45° field of view:
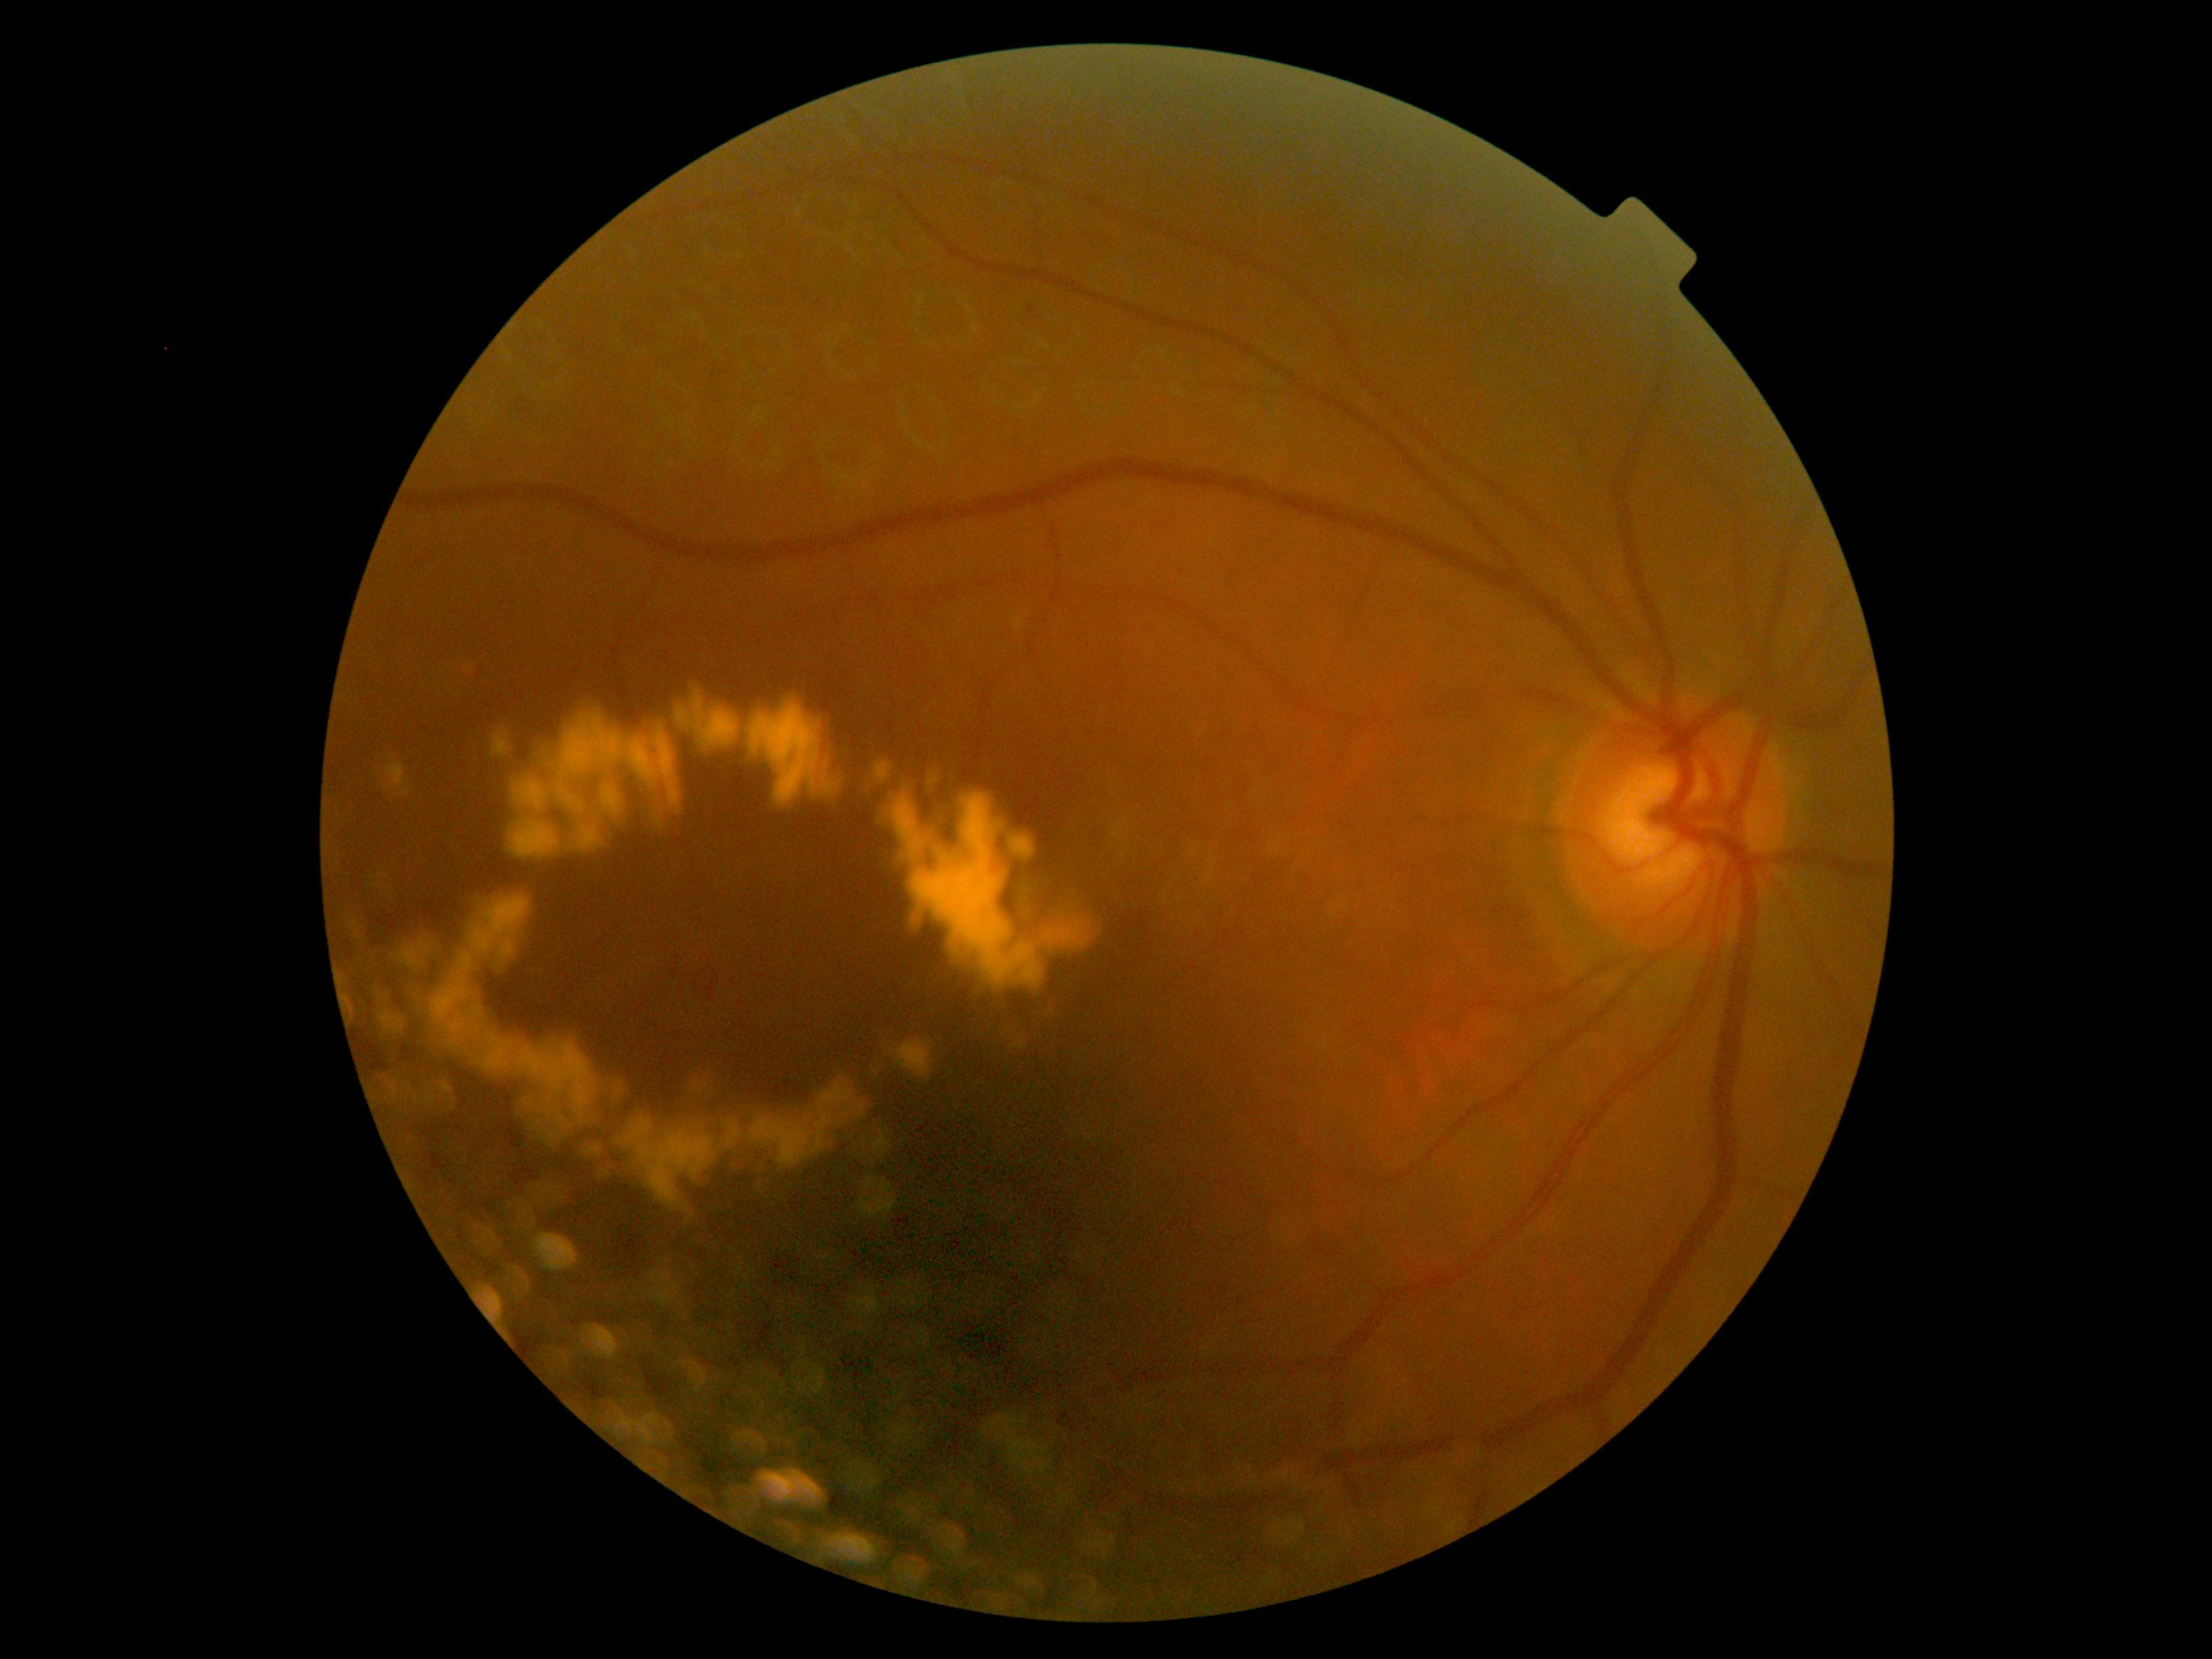

DR severity is moderate non-proliferative diabetic retinopathy (grade 2).
No SEs identified.
Smaller MAs around 1031:314.
EXs located at [432, 890, 871, 1222]; [876, 762, 1104, 1001]; [874, 760, 893, 785]; [386, 762, 411, 799]; [399, 937, 433, 967]; [490, 729, 512, 757]; [379, 1008, 406, 1039]; [887, 1039, 935, 1081]; [508, 681, 845, 860].
No HEs identified.